Fundus photo. No pharmacologic dilation. Image size 848x848. Camera: NIDEK AFC-230:
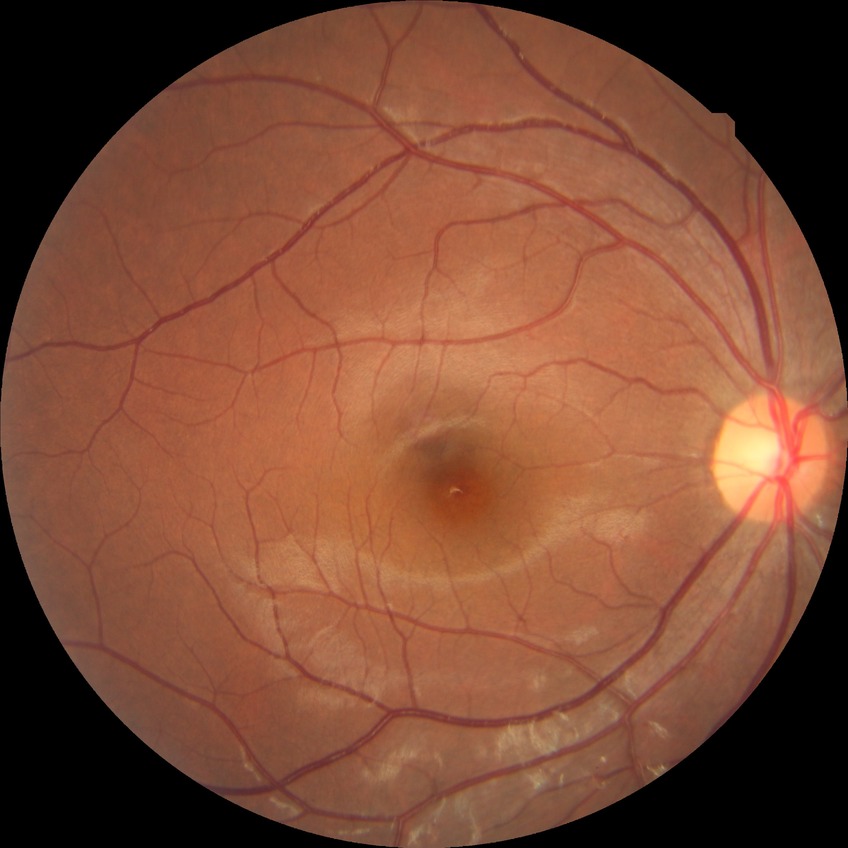

  davis_grade: no diabetic retinopathy